Infant wide-field fundus photograph: 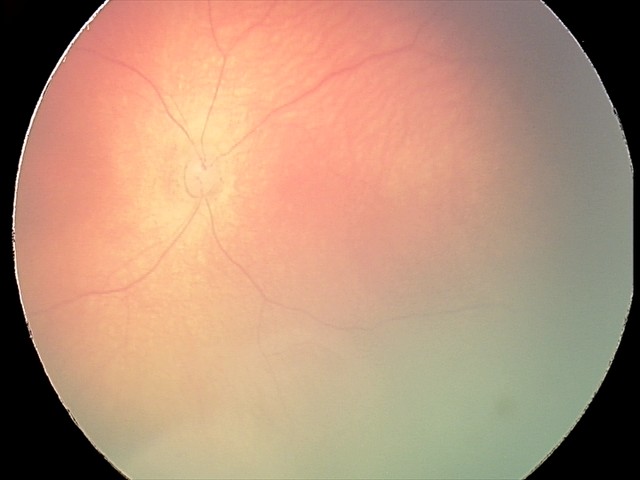

Examination diagnosed as retinal hemorrhages.